Clarity RetCam 3, 130° FOV. Pediatric retinal photograph (wide-field).
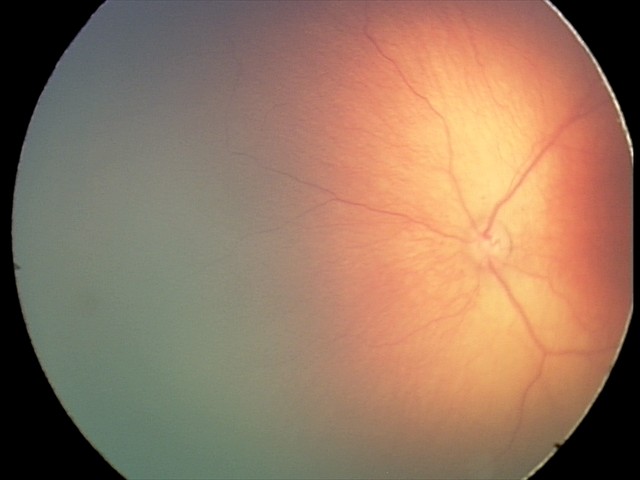
Series diagnosed as retinopathy of prematurity stage 2. Plus disease absent.